Retinal fundus photograph · 45-degree field of view.
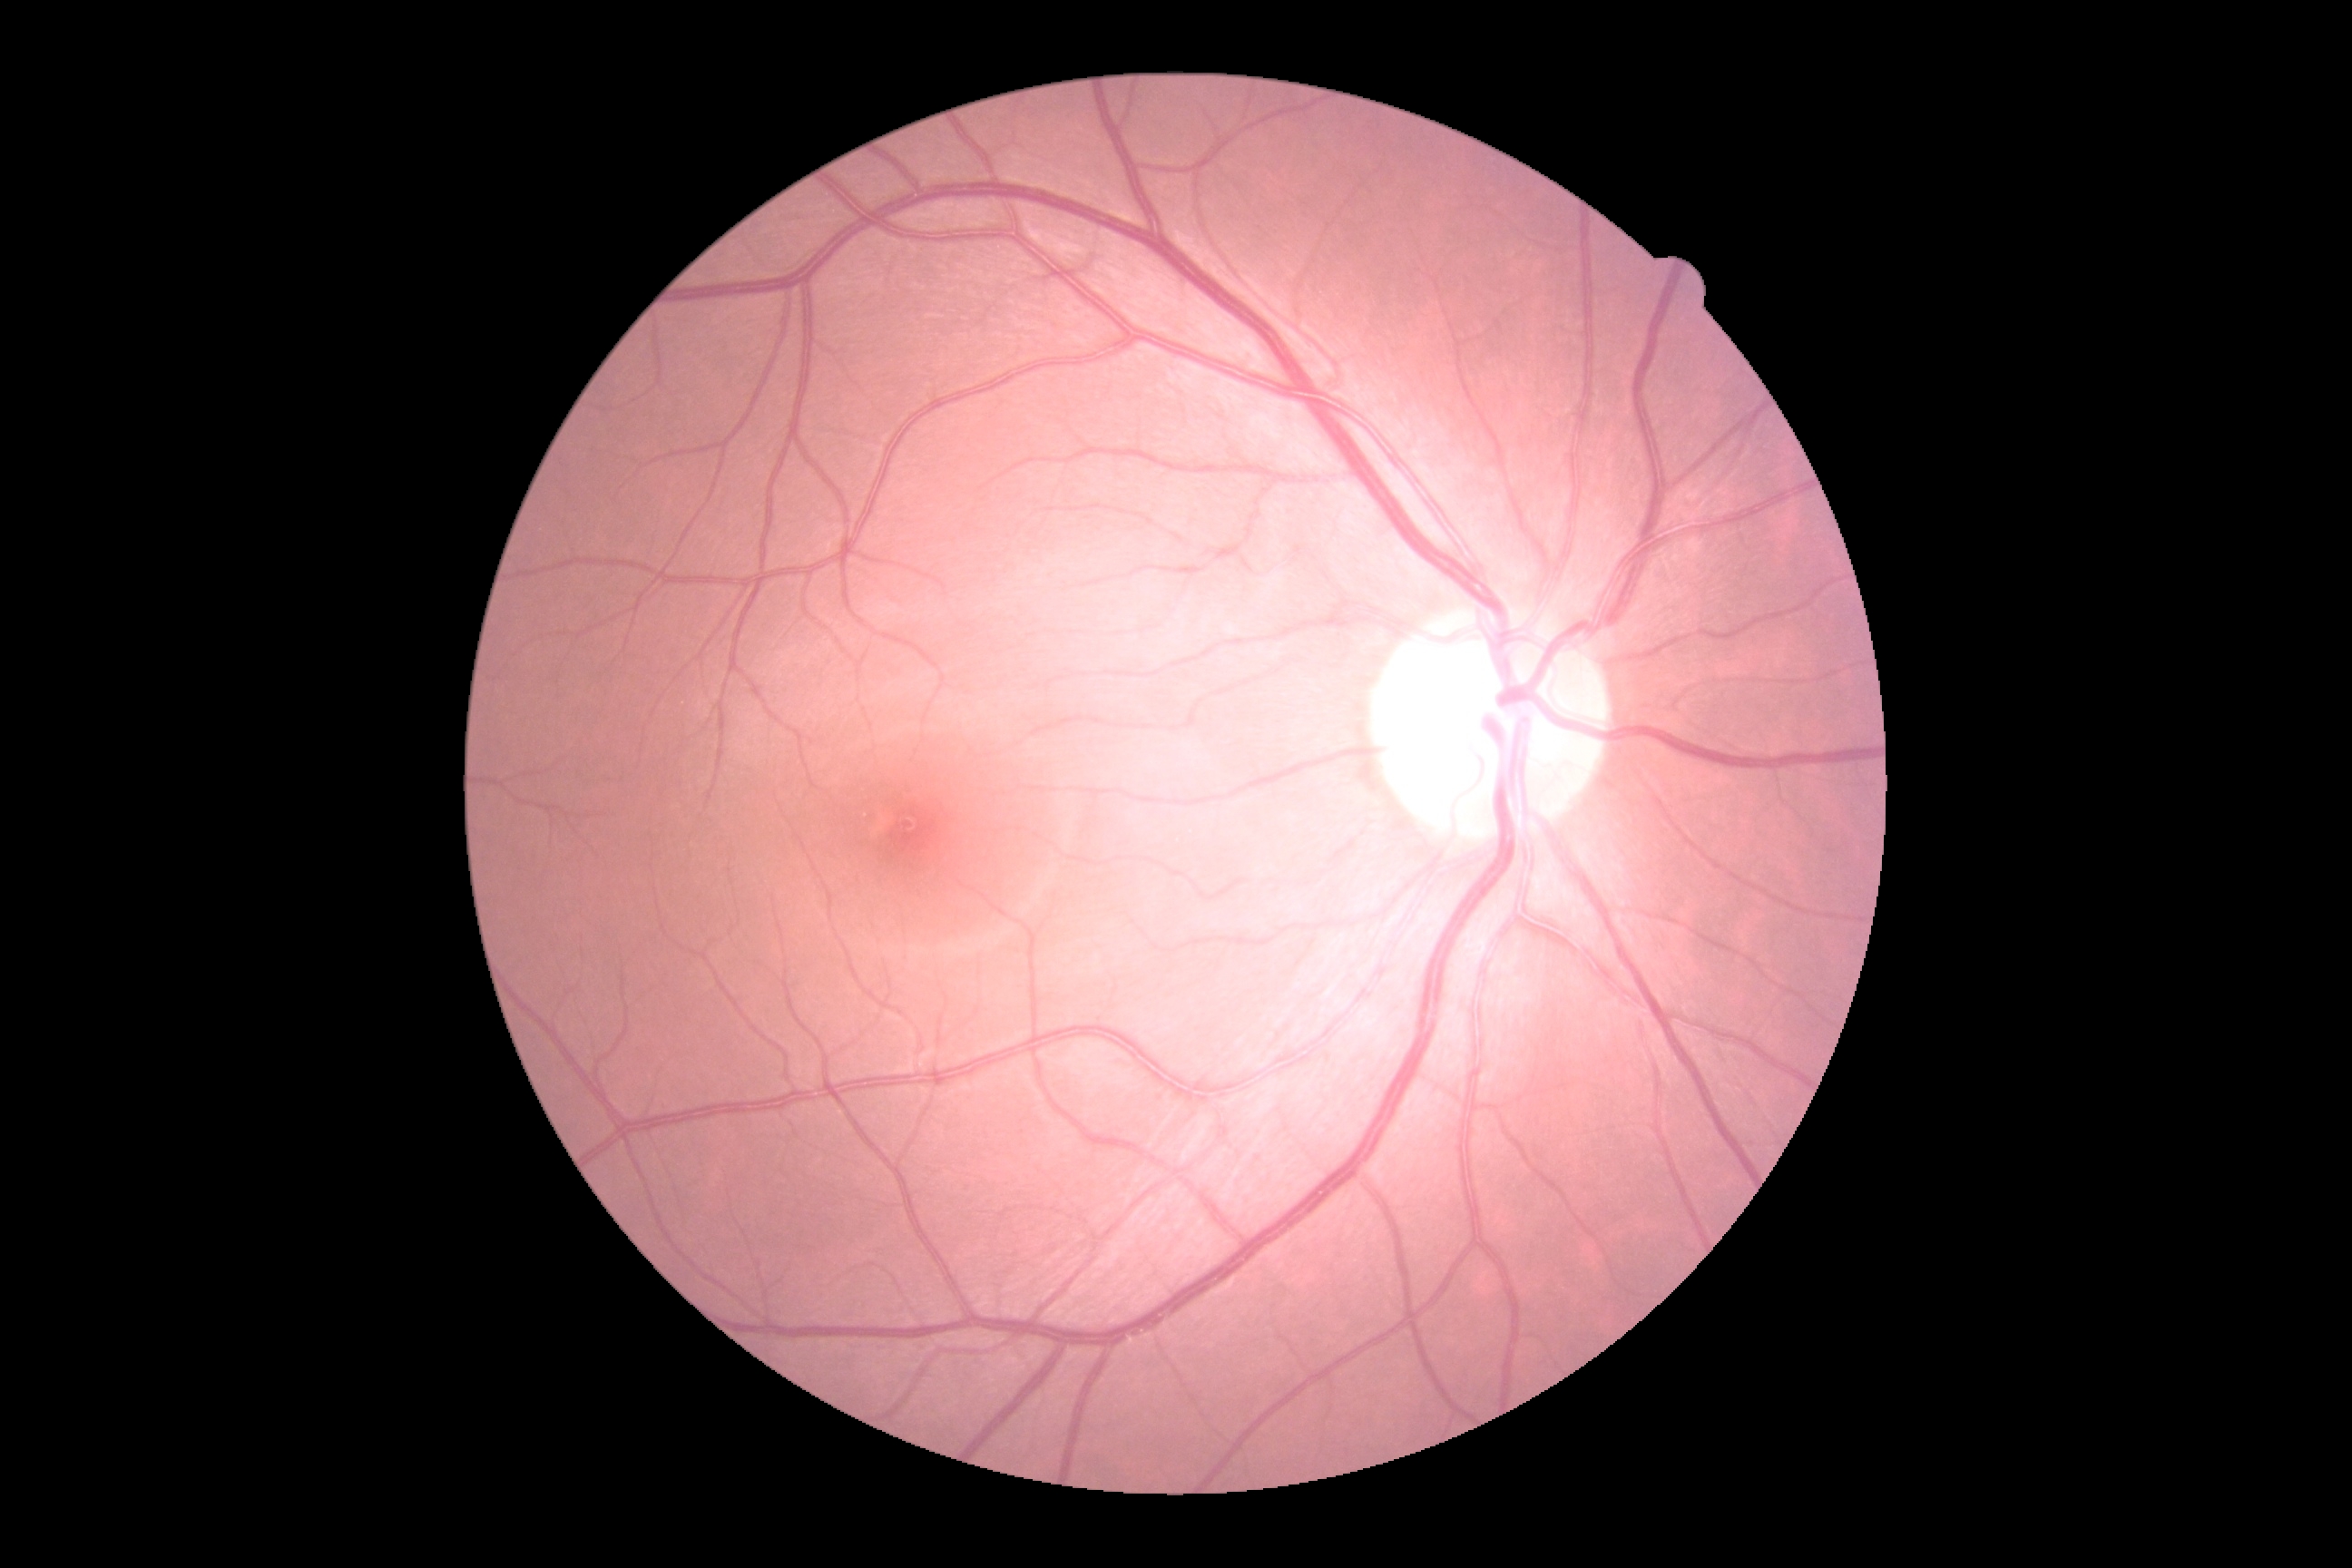
DR is grade 0 (no apparent retinopathy).